Nonmydriatic. NIDEK AFC-230. 45° field of view.
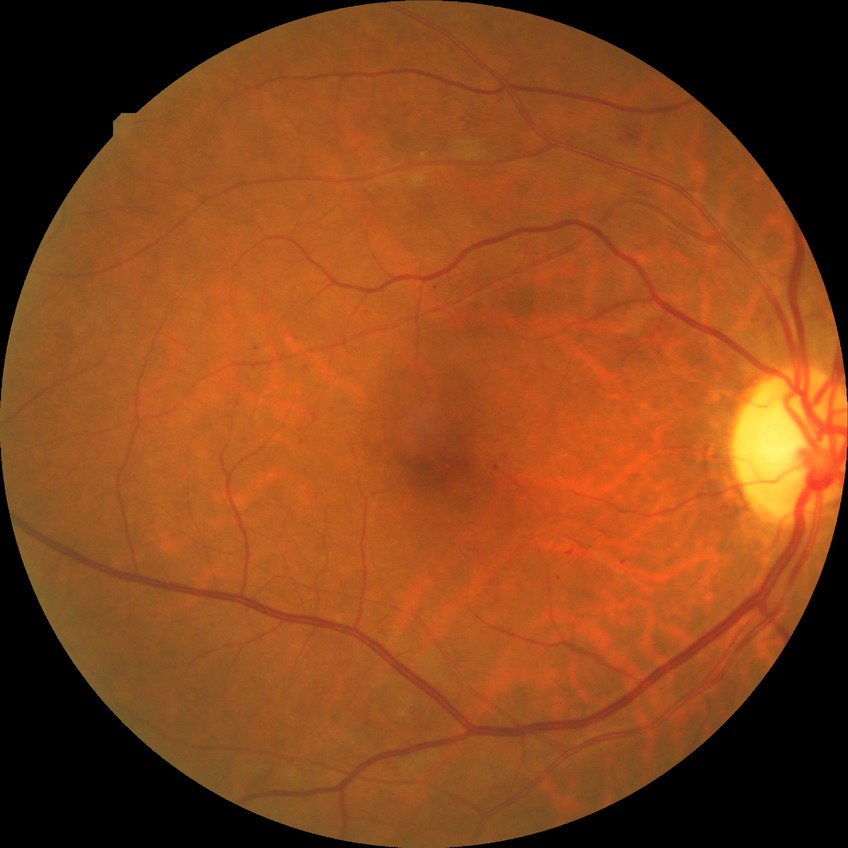

Diabetic retinopathy (DR): PPDR (pre-proliferative diabetic retinopathy).